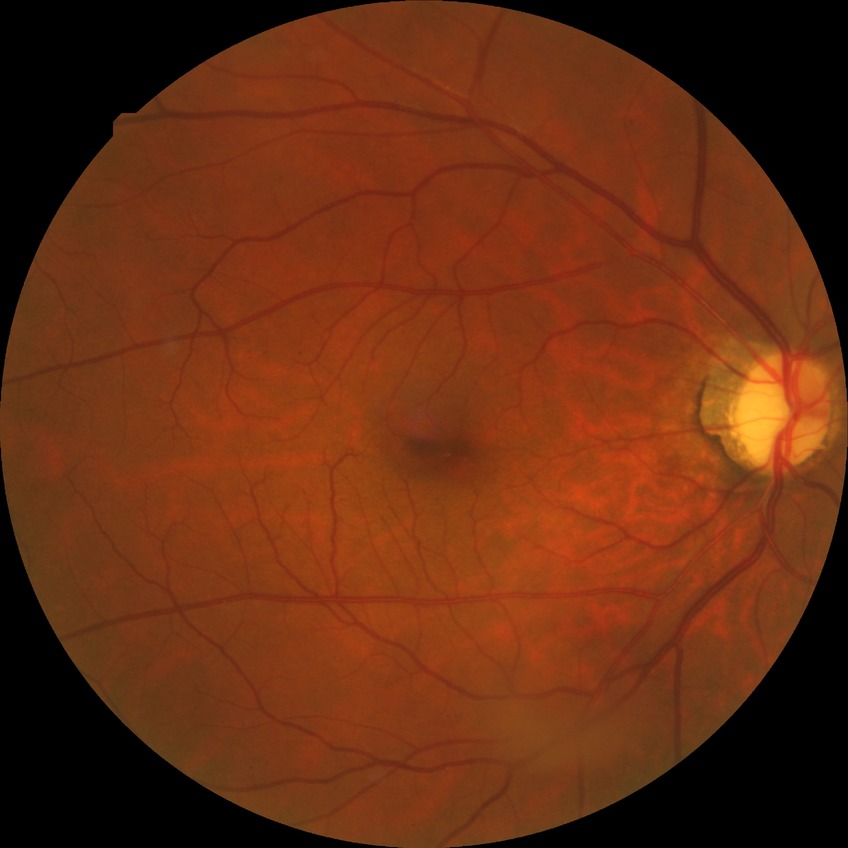
Diabetic retinopathy (DR) is simple diabetic retinopathy (SDR).